Fundus photo. FOV: 45 degrees. 1960x1897px.
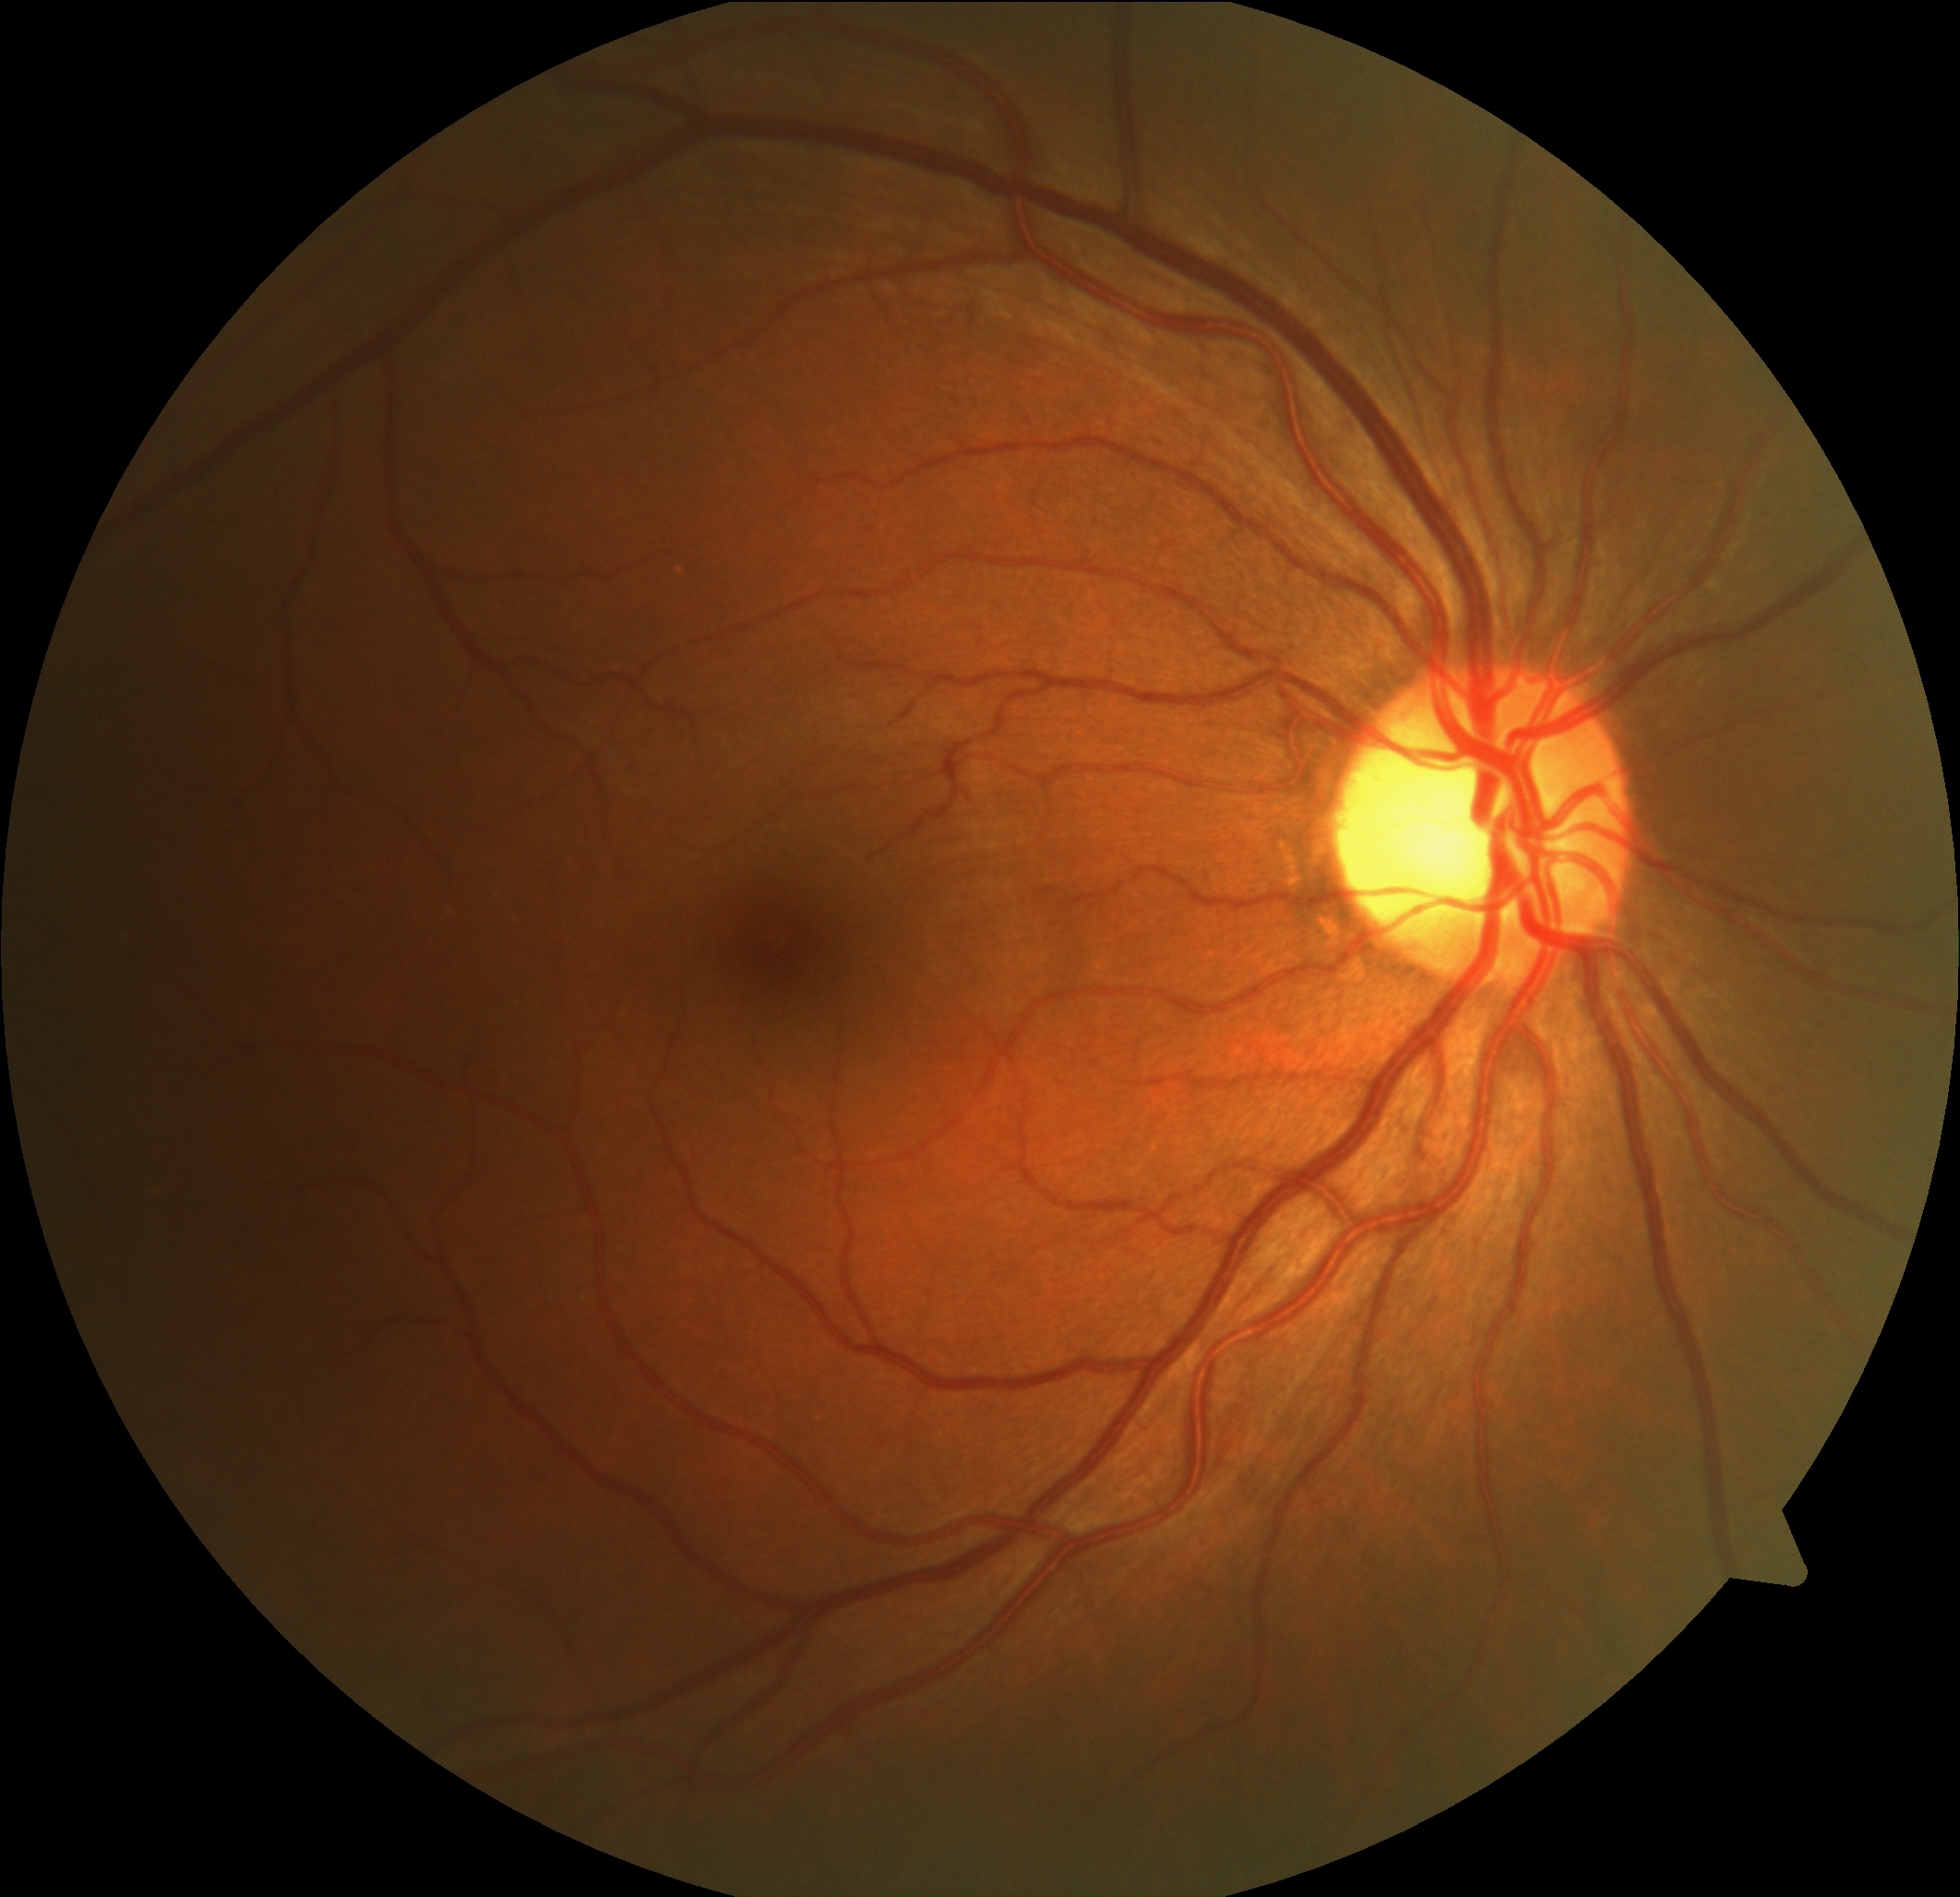

DR severity: no apparent diabetic retinopathy (grade 0) — no visible signs of diabetic retinopathy.
No apparent diabetic retinopathy.